RetCam wide-field infant fundus image; Clarity RetCam 3, 130° FOV
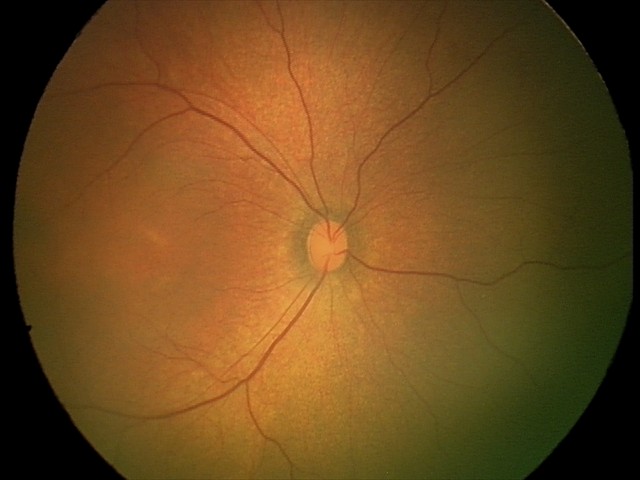 Impression: physiological appearance with no retinal pathology.